No pharmacologic dilation. 45 degree fundus photograph
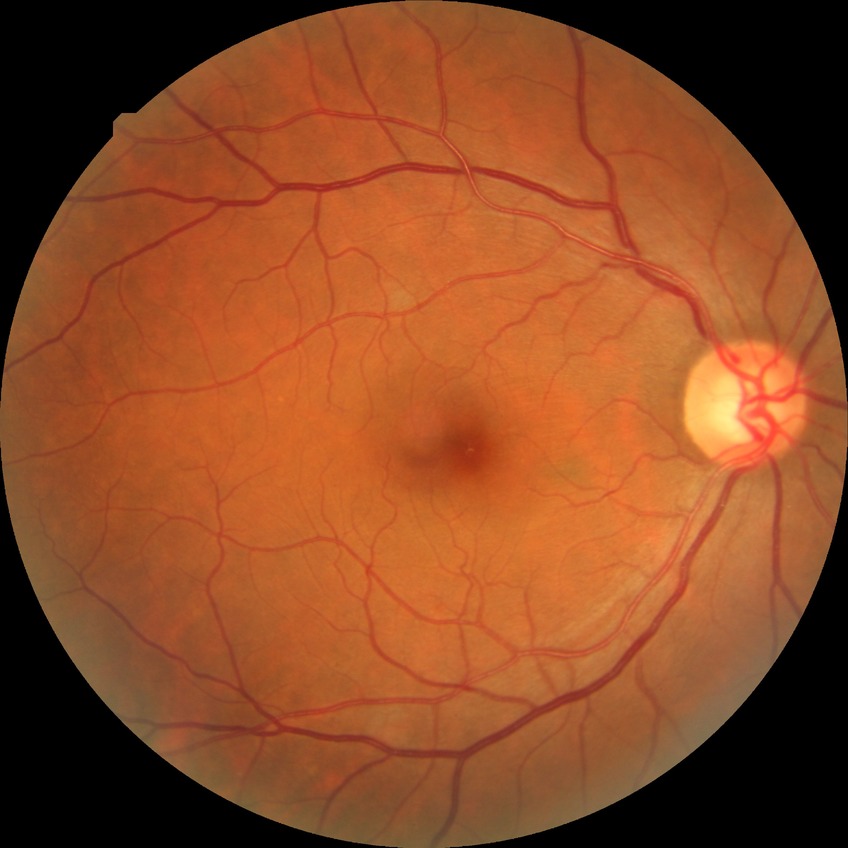
Diabetic retinopathy (DR): SDR (simple diabetic retinopathy).